Topcon TRC-50DX. Field includes the optic disc and macula. 50-degree field of view. 2228 by 1652 pixels
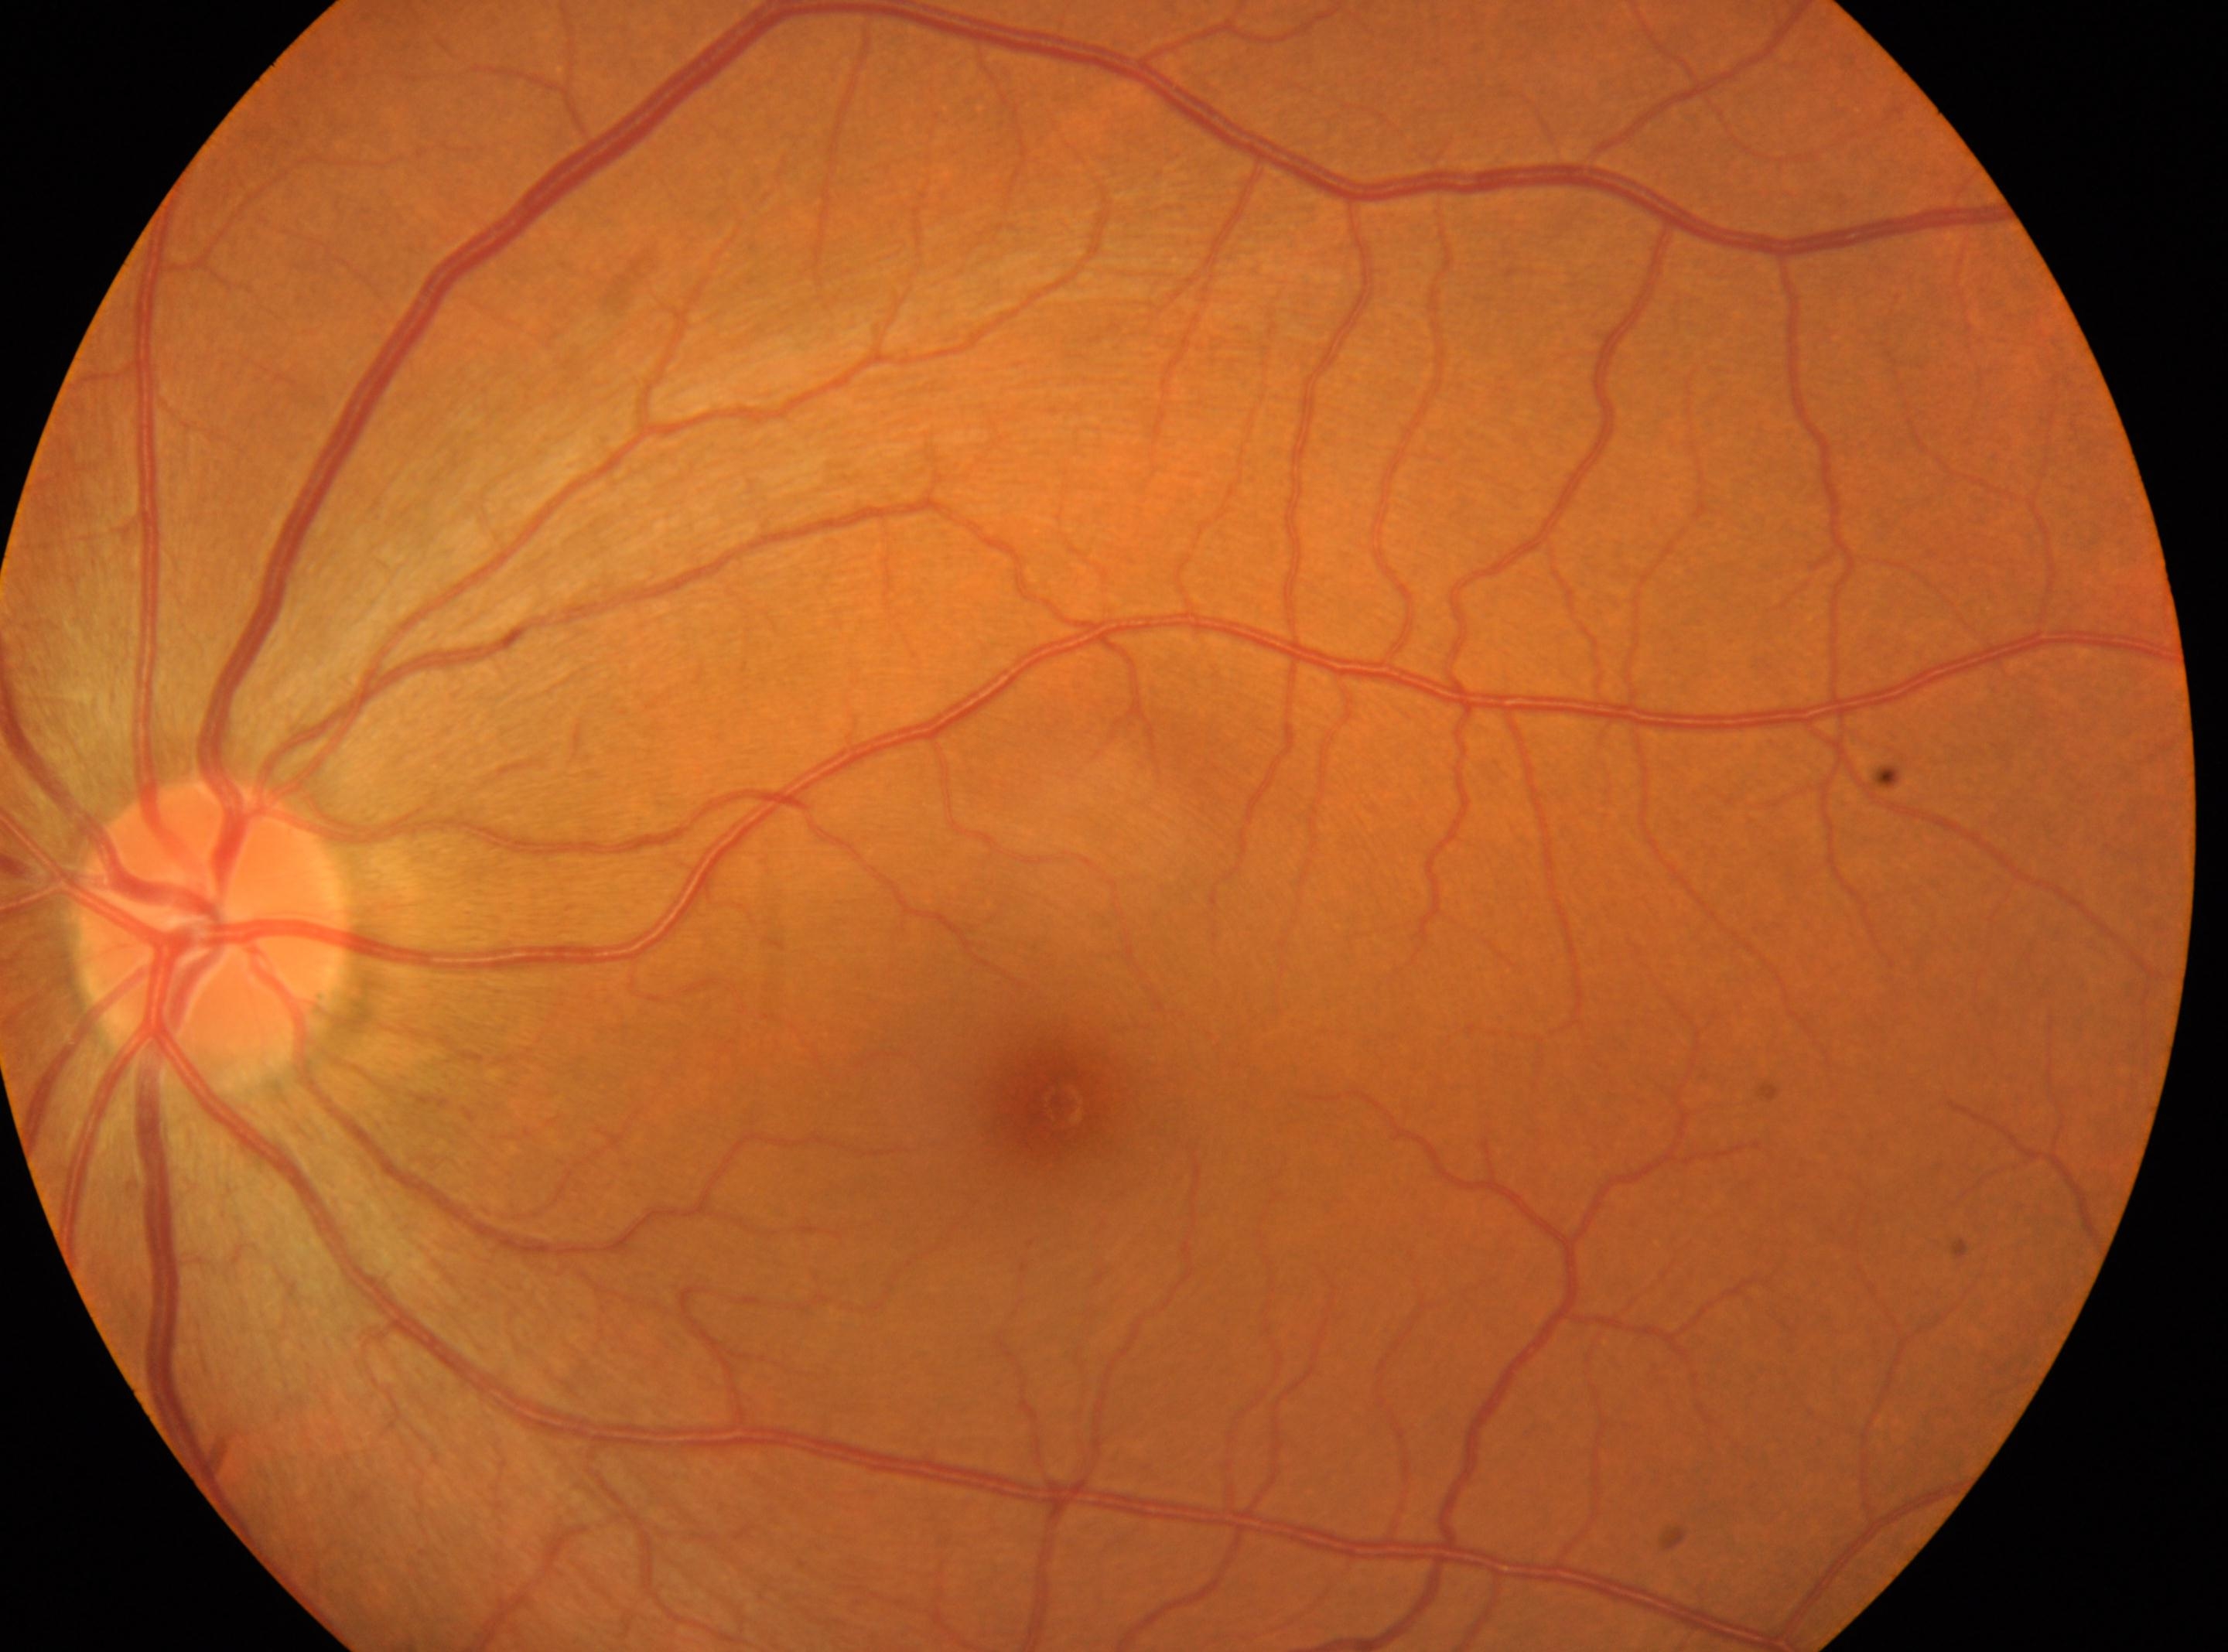
disc center@(x=209, y=928)
fovea centralis@(x=1058, y=1103)
left eye
diabetic retinopathy (DR)@grade 0 — no visible signs of diabetic retinopathy